CFP; 2212x1659px: 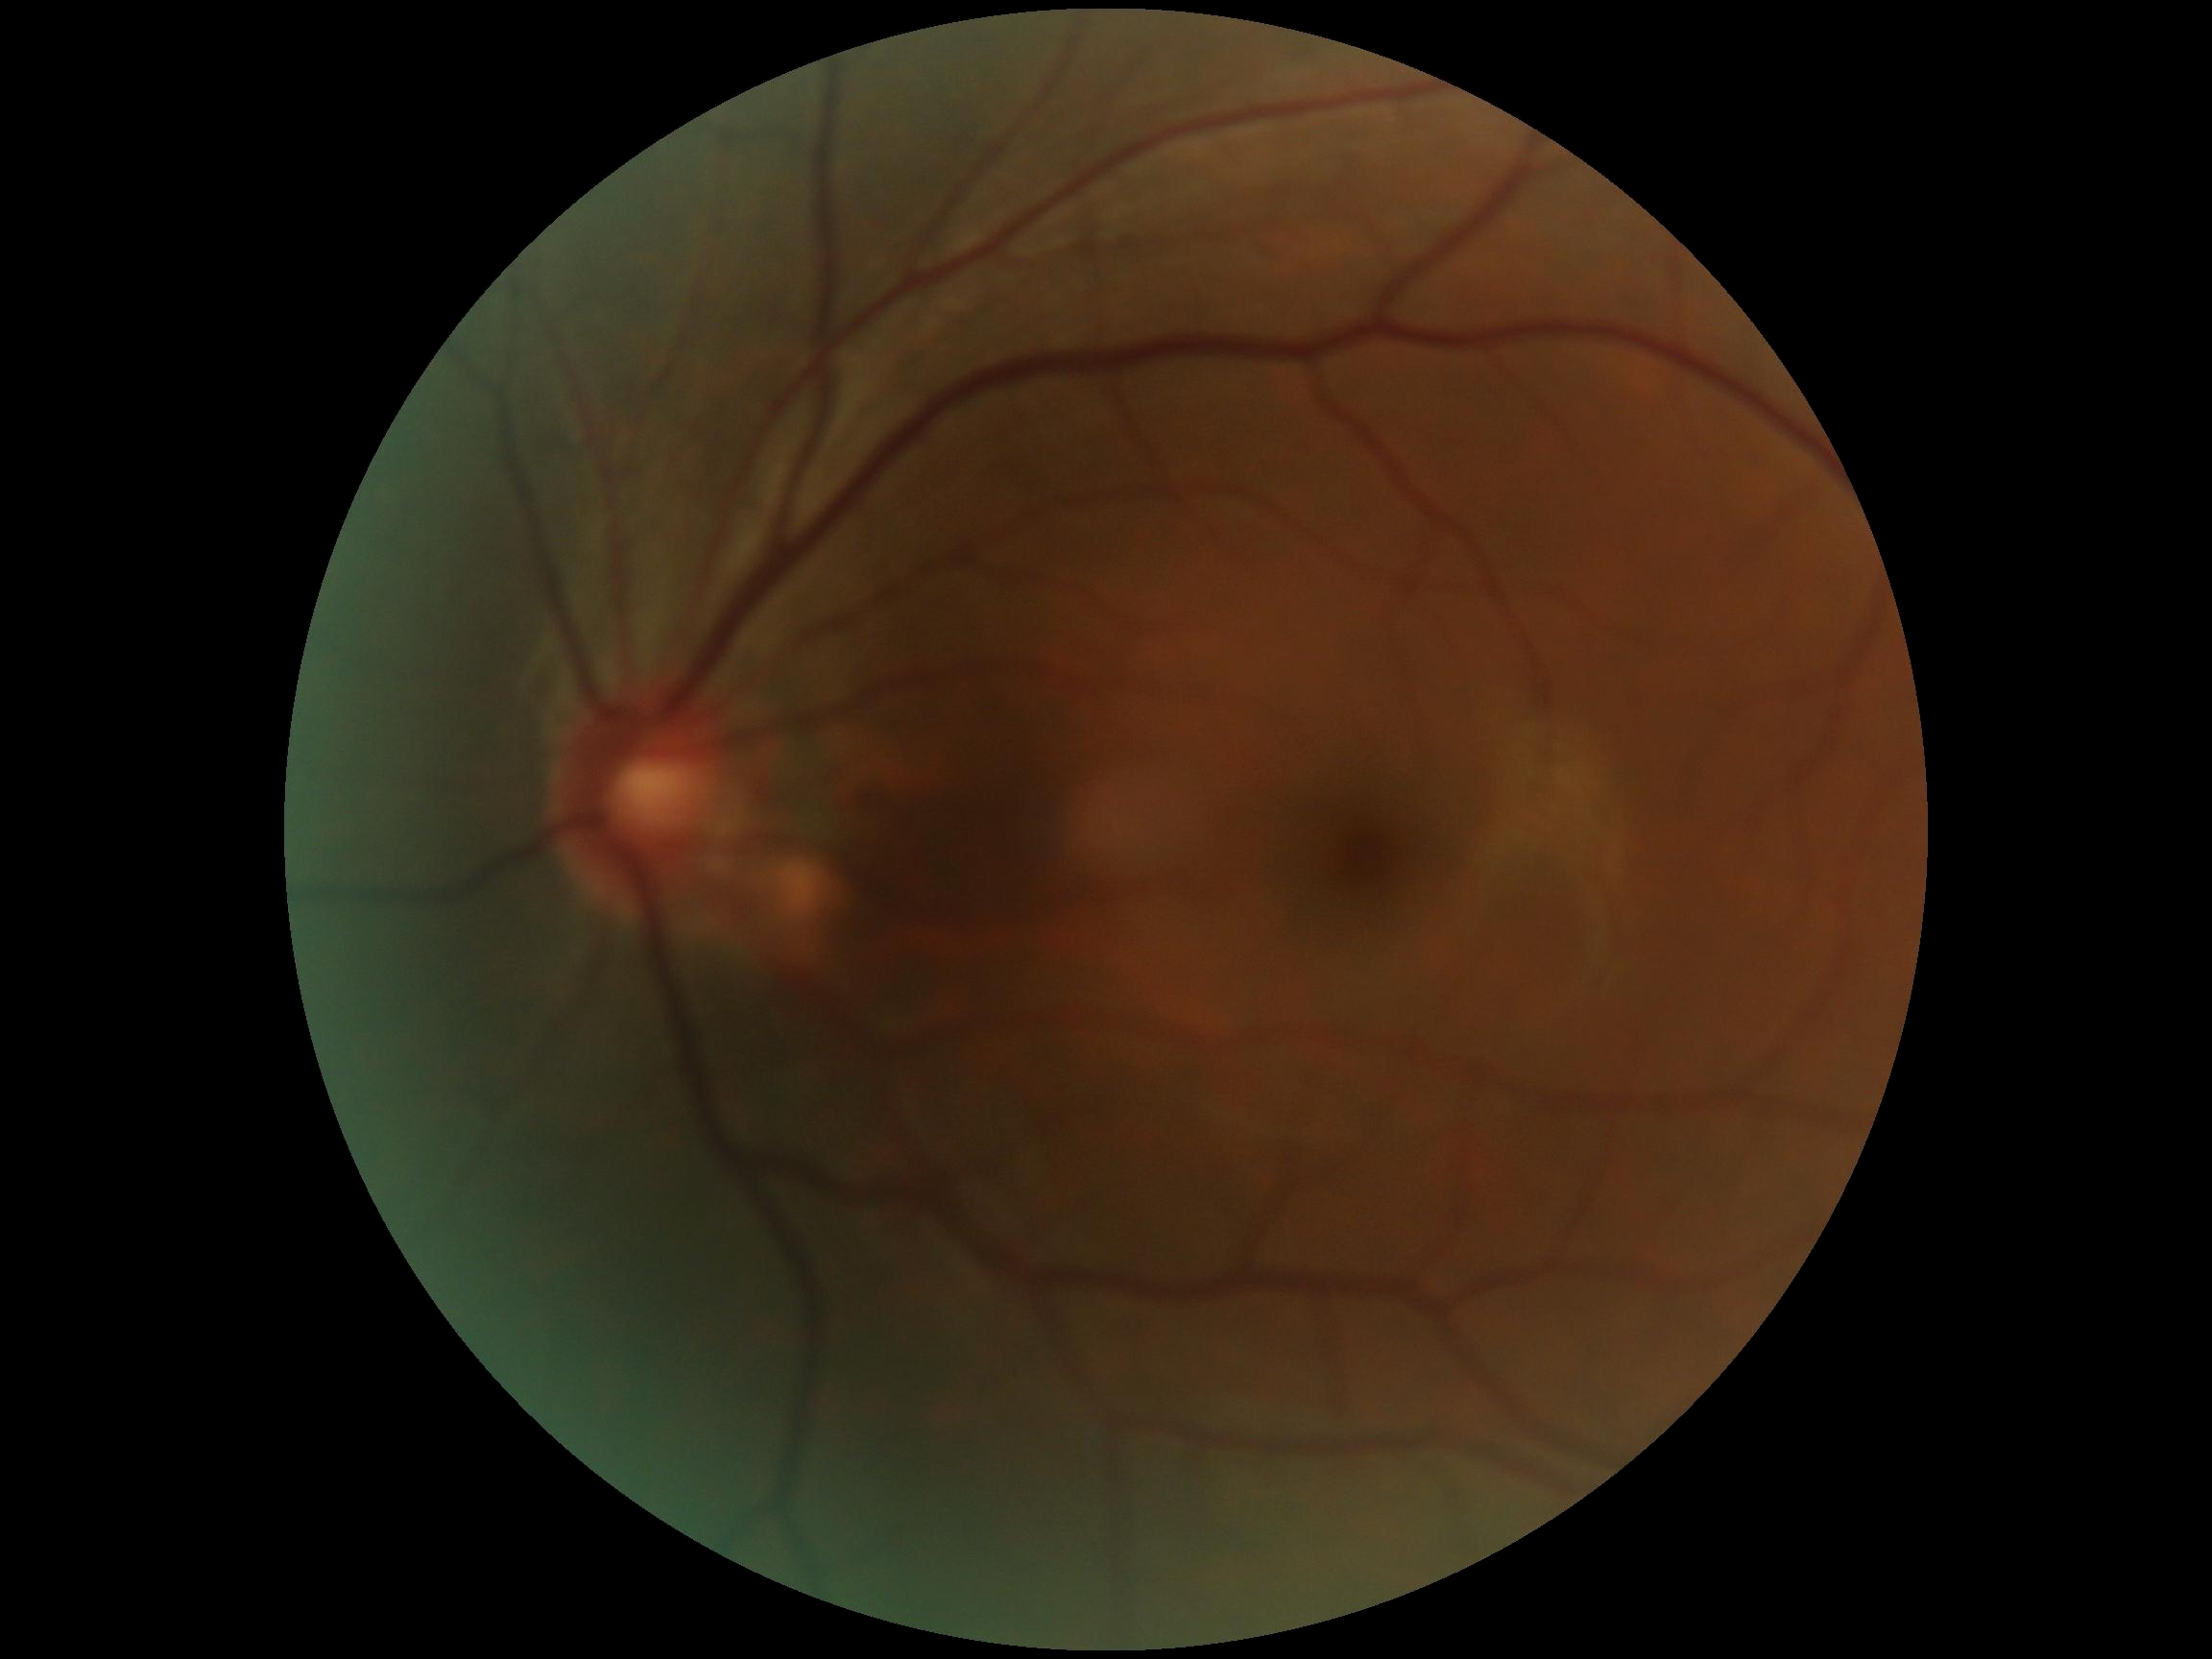 DR stage: 0